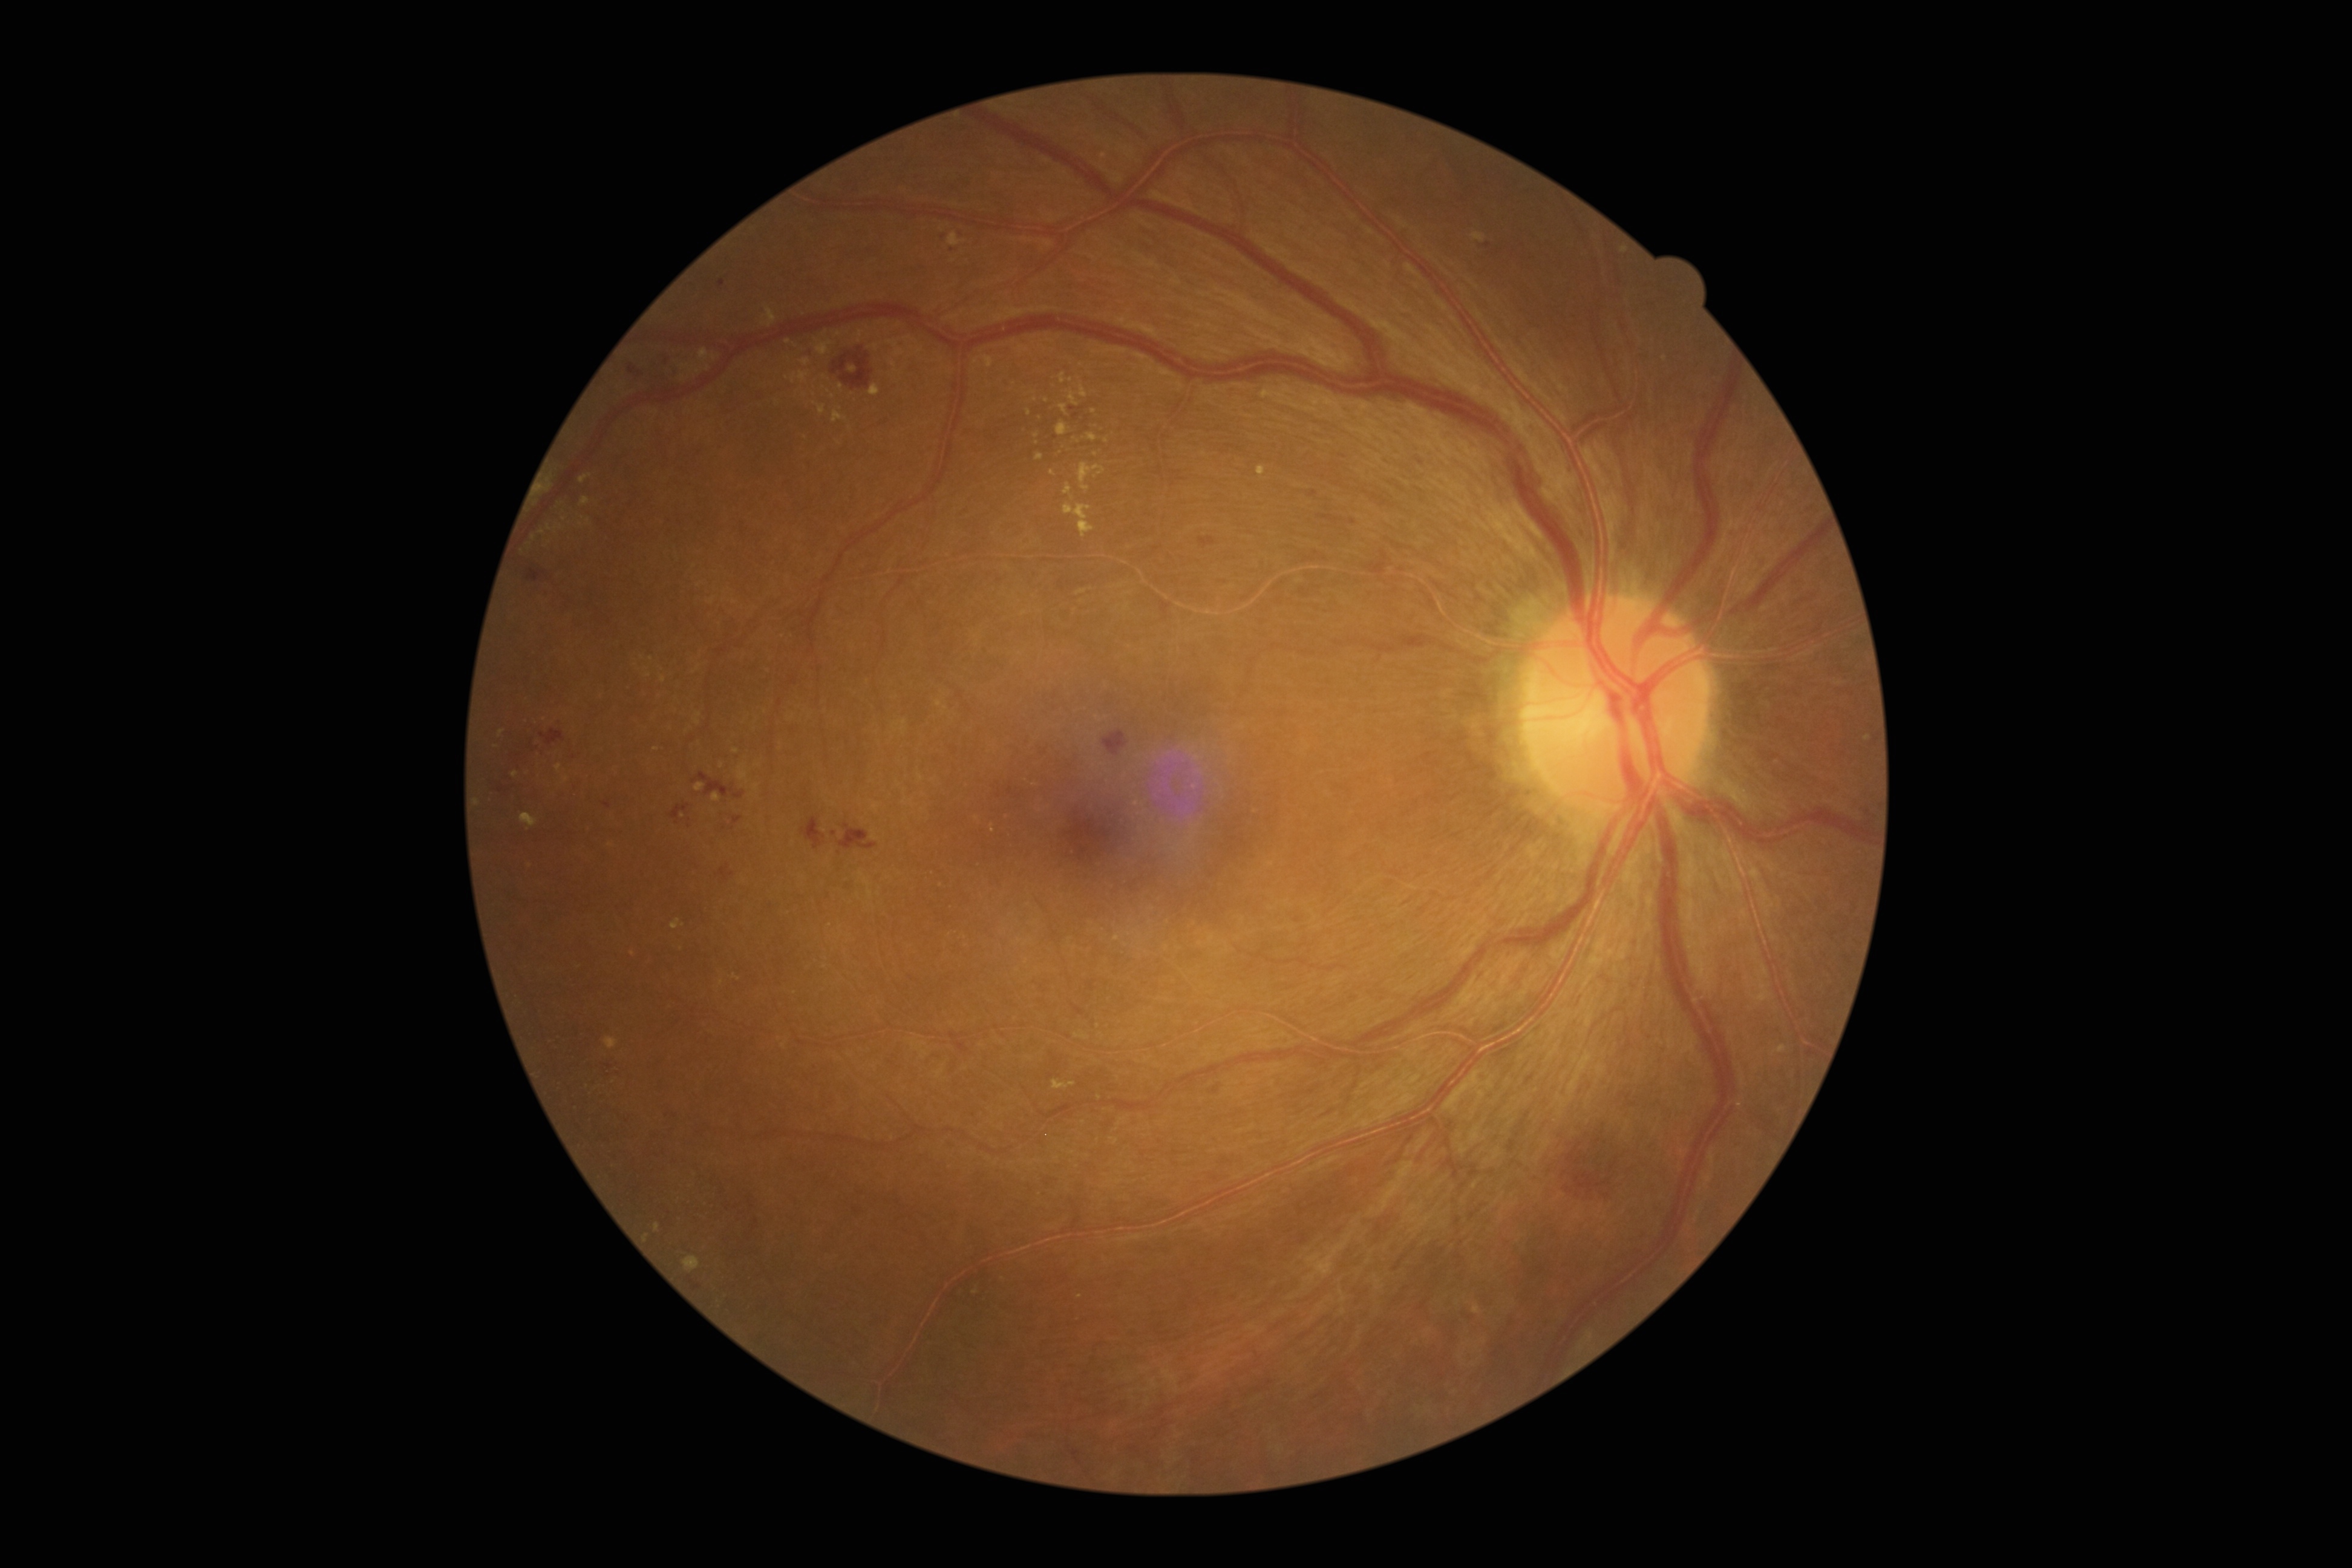

partial: true
dr_grade: 2
lesions:
  se: []
  ex:
    - left=1059, top=405, right=1068, bottom=416
    - left=521, top=814, right=538, bottom=828
    - left=713, top=794, right=722, bottom=803
    - left=694, top=713, right=701, bottom=727
    - left=1260, top=389, right=1267, bottom=397
    - left=887, top=341, right=906, bottom=358
    - left=604, top=1037, right=619, bottom=1051
    - left=834, top=332, right=843, bottom=338
    - left=1472, top=233, right=1486, bottom=243
    - left=991, top=825, right=995, bottom=833
    - left=1057, top=422, right=1069, bottom=436
    - left=1064, top=503, right=1094, bottom=538
  ex_small:
    - (833; 397)
    - (722; 766)
    - (722; 984)
    - (737; 978)
    - (1046; 401)
    - (1094; 412)
    - (1096; 454)
    - (841; 388)
  ma:
    - left=718, top=280, right=725, bottom=289
    - left=1484, top=241, right=1492, bottom=249
    - left=1310, top=491, right=1318, bottom=498
    - left=602, top=802, right=612, bottom=810
    - left=1350, top=518, right=1356, bottom=526
  ma_small:
    - (952; 250)
    - (834; 835)
    - (944; 238)
  he:
    - left=1198, top=537, right=1217, bottom=547
    - left=629, top=364, right=644, bottom=379
    - left=800, top=817, right=826, bottom=850
    - left=1103, top=730, right=1129, bottom=758
    - left=539, top=729, right=566, bottom=747
    - left=832, top=348, right=873, bottom=390
    - left=527, top=569, right=546, bottom=583
    - left=1073, top=414, right=1080, bottom=422
    - left=733, top=816, right=742, bottom=825
    - left=1570, top=1168, right=1611, bottom=1196
    - left=670, top=803, right=689, bottom=821
    - left=838, top=823, right=878, bottom=850
    - left=693, top=774, right=745, bottom=800
    - left=716, top=866, right=735, bottom=881